45° FOV · 1380 x 1382 pixels:
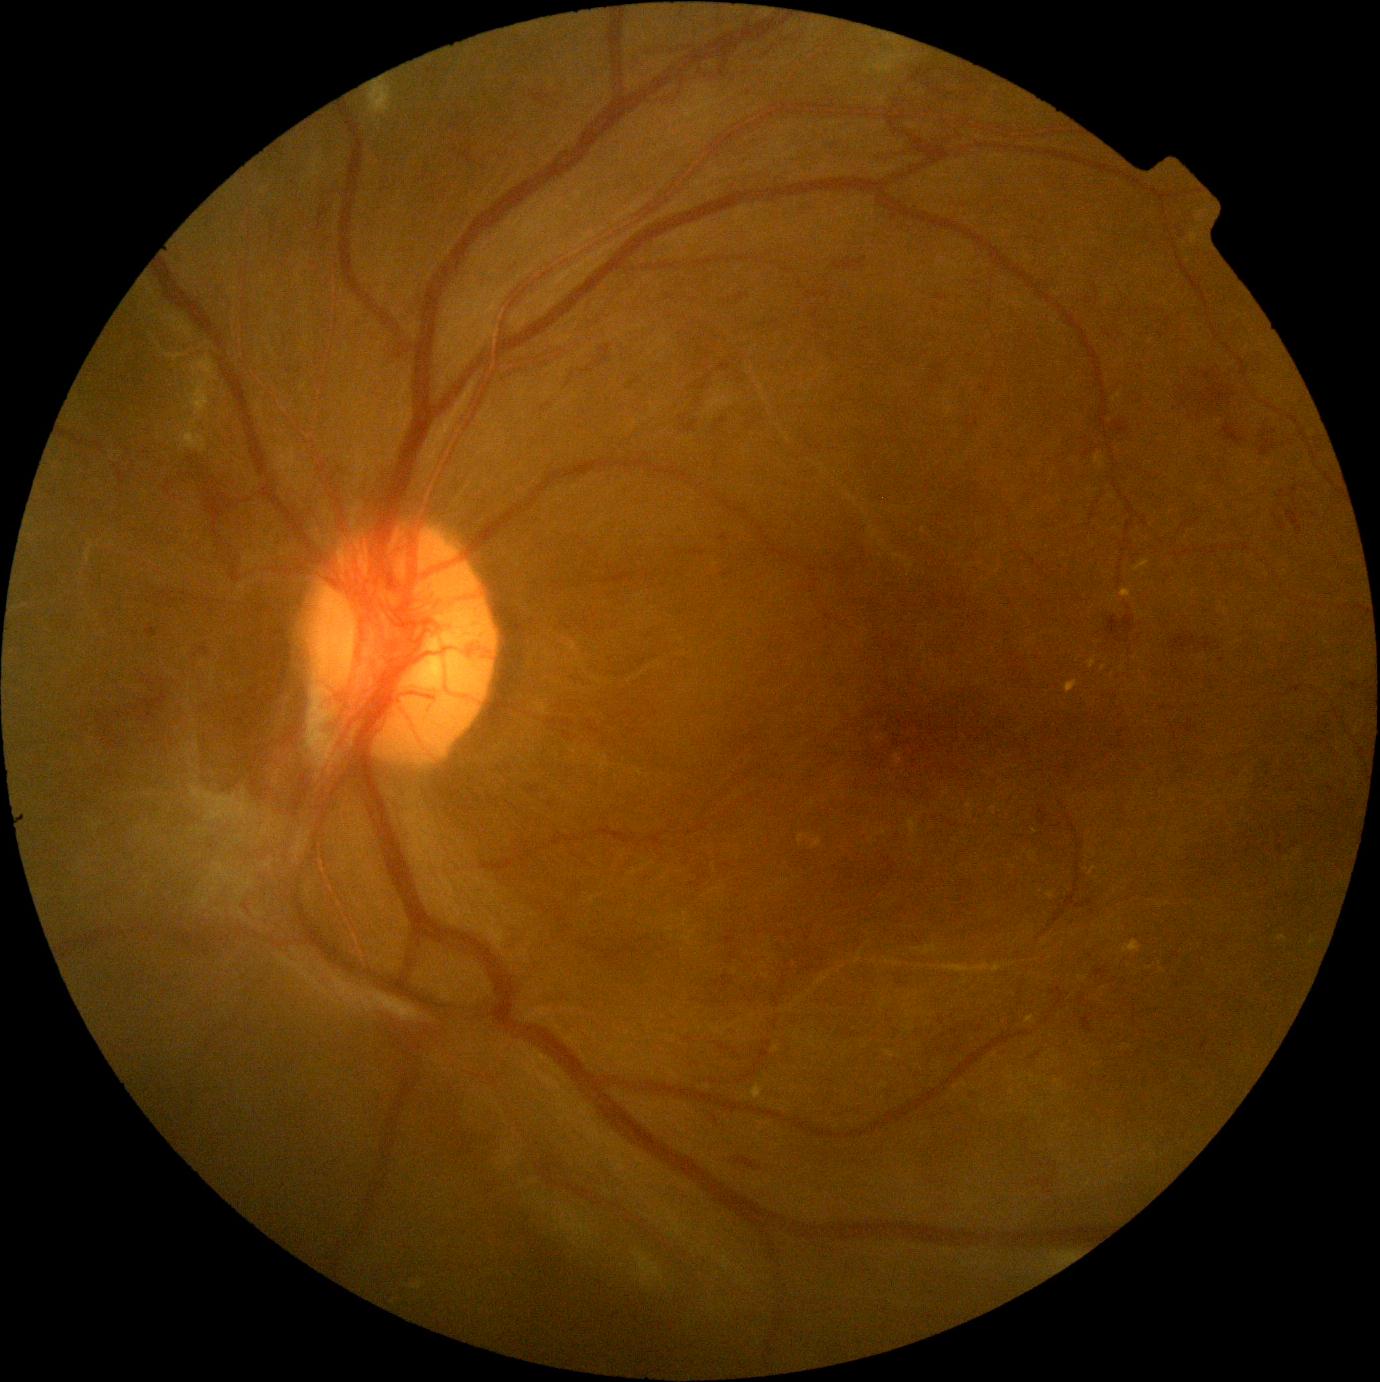
Diabetic retinopathy (DR) is grade 4.
DR class: proliferative diabetic retinopathy.